DR severity per modified Davis staging: 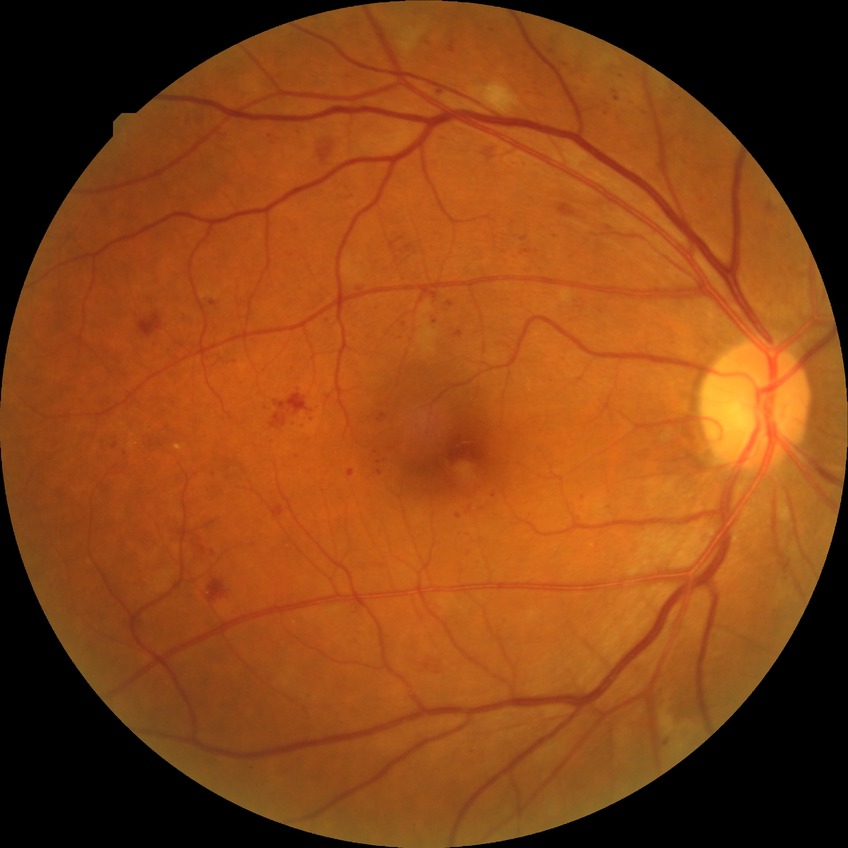

diabetic retinopathy grade: pre-proliferative diabetic retinopathy.